2212 by 1659 pixels.
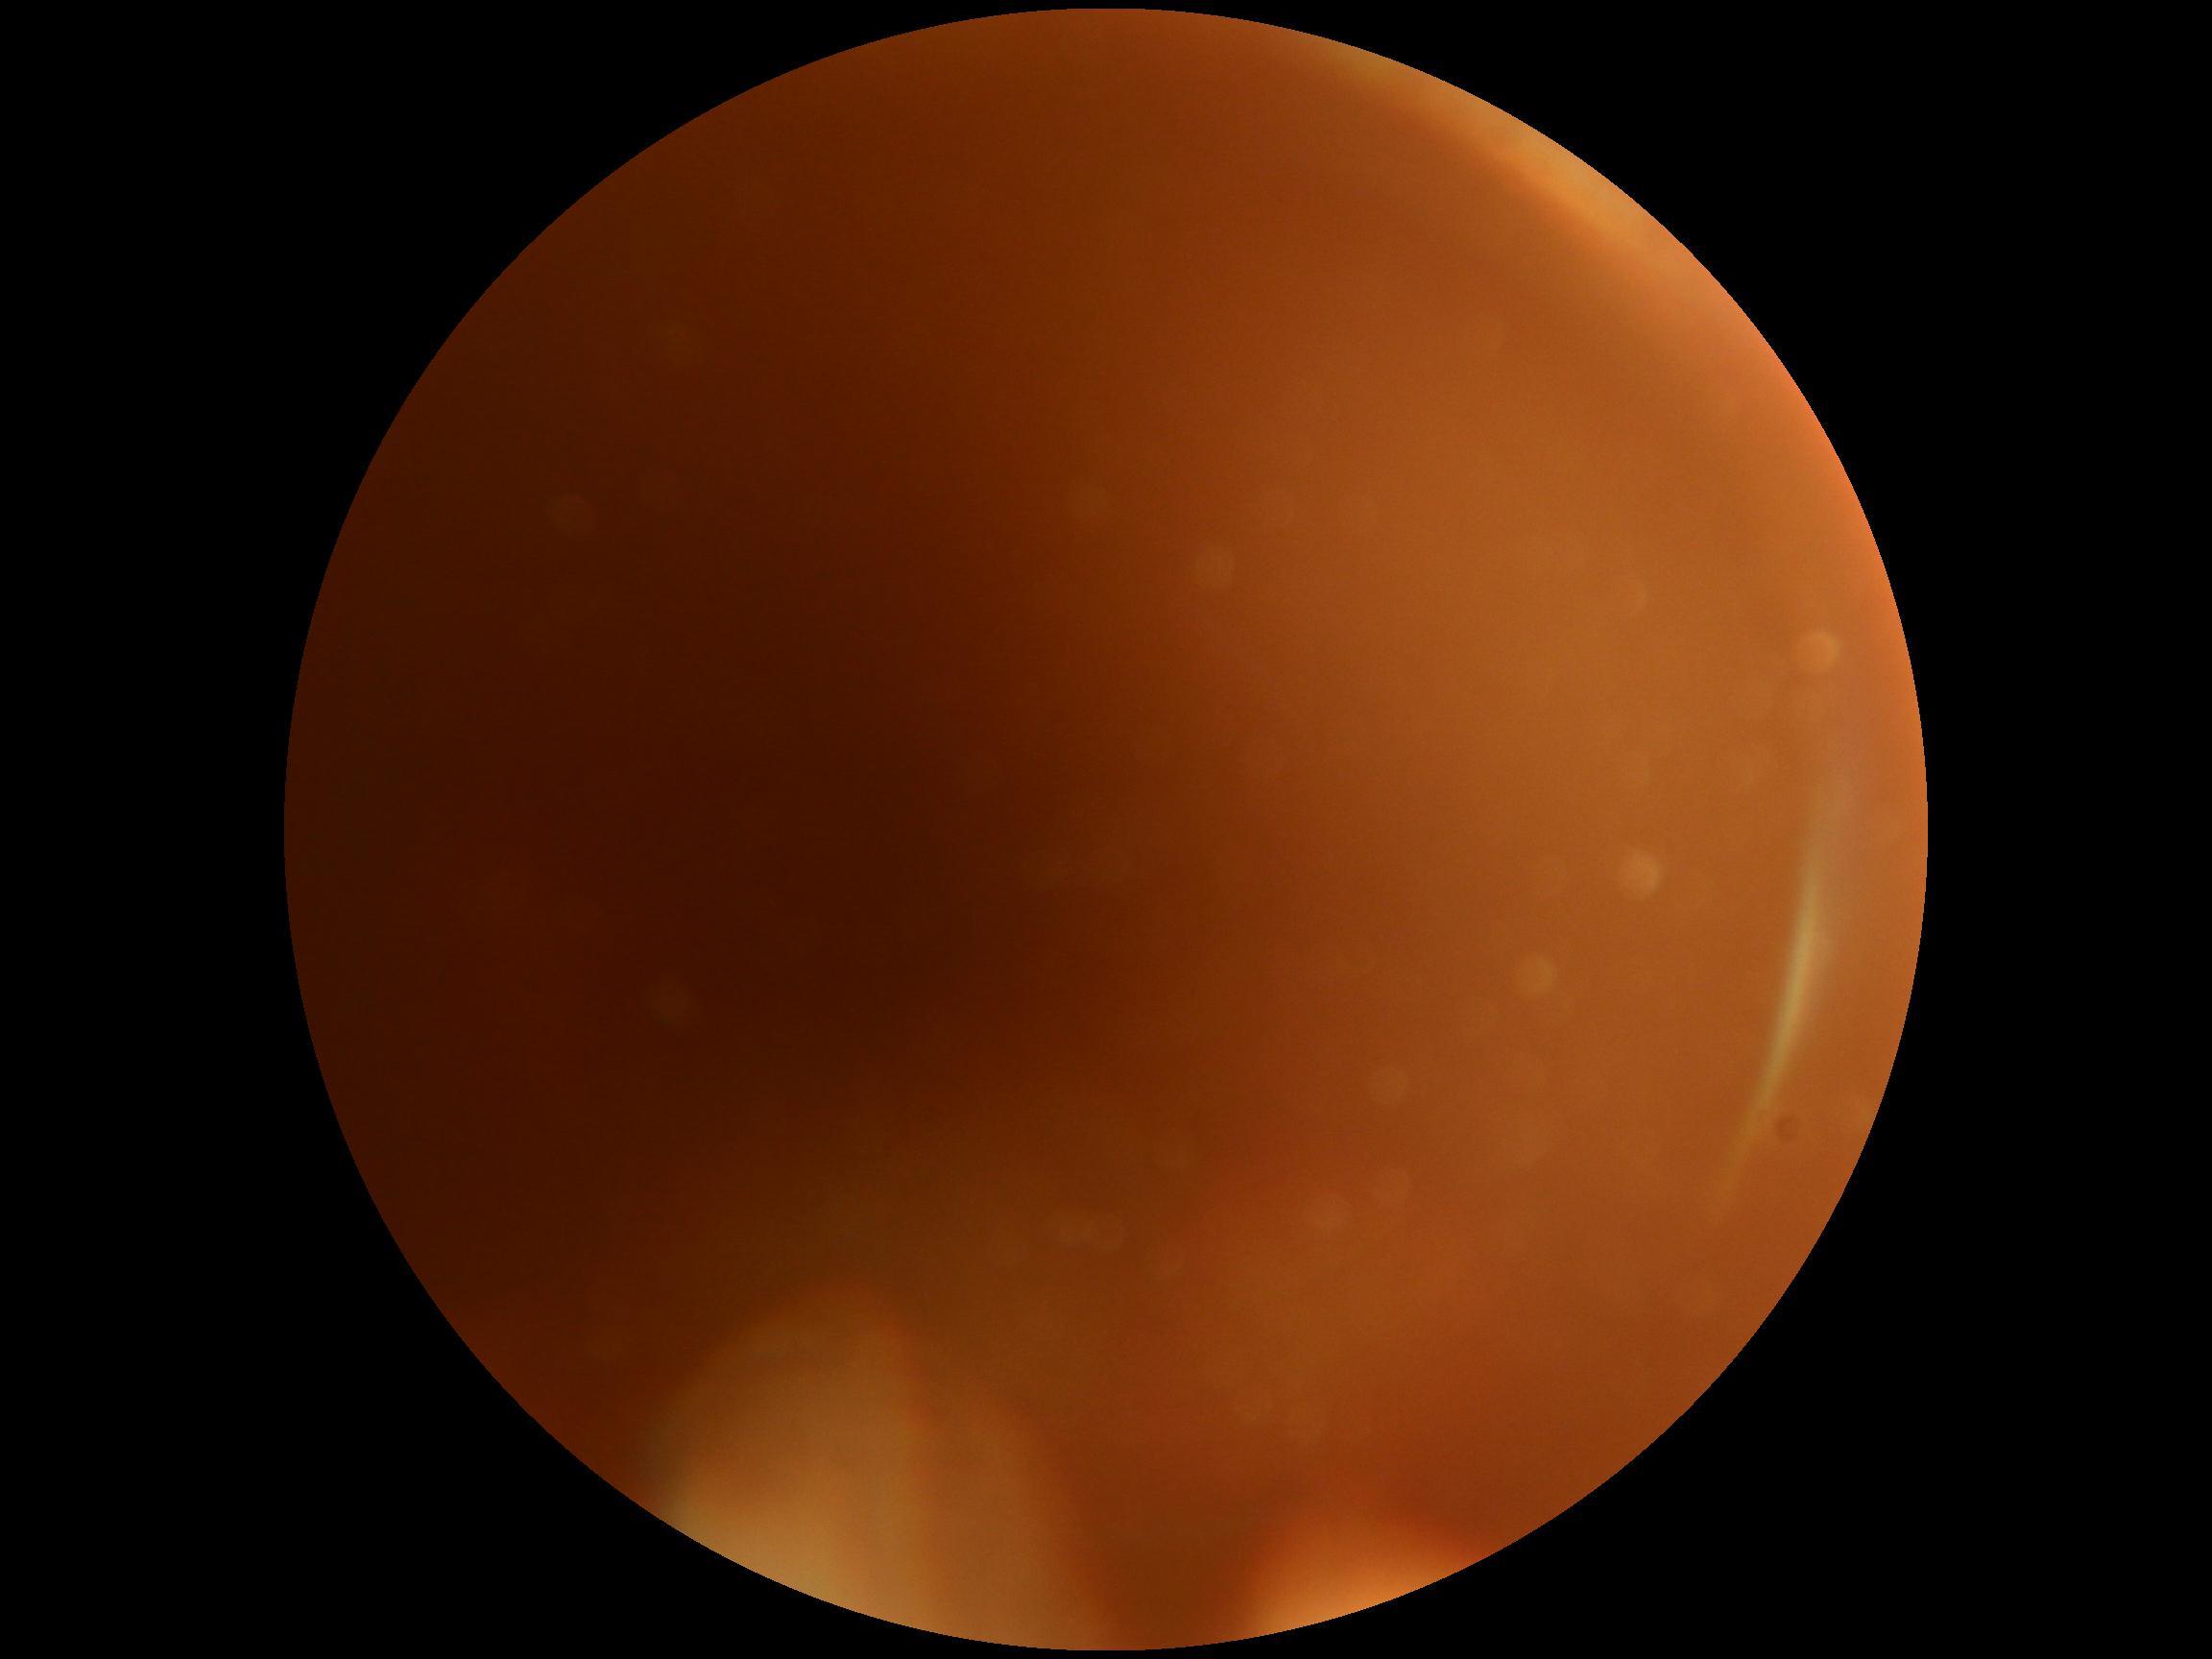
The image cannot be graded for diabetic retinopathy. Retinopathy: ungradable due to poor image quality.